No pharmacologic dilation · 45-degree field of view · acquired with a NIDEK AFC-230 · image size 848x848 · posterior pole color fundus photograph.
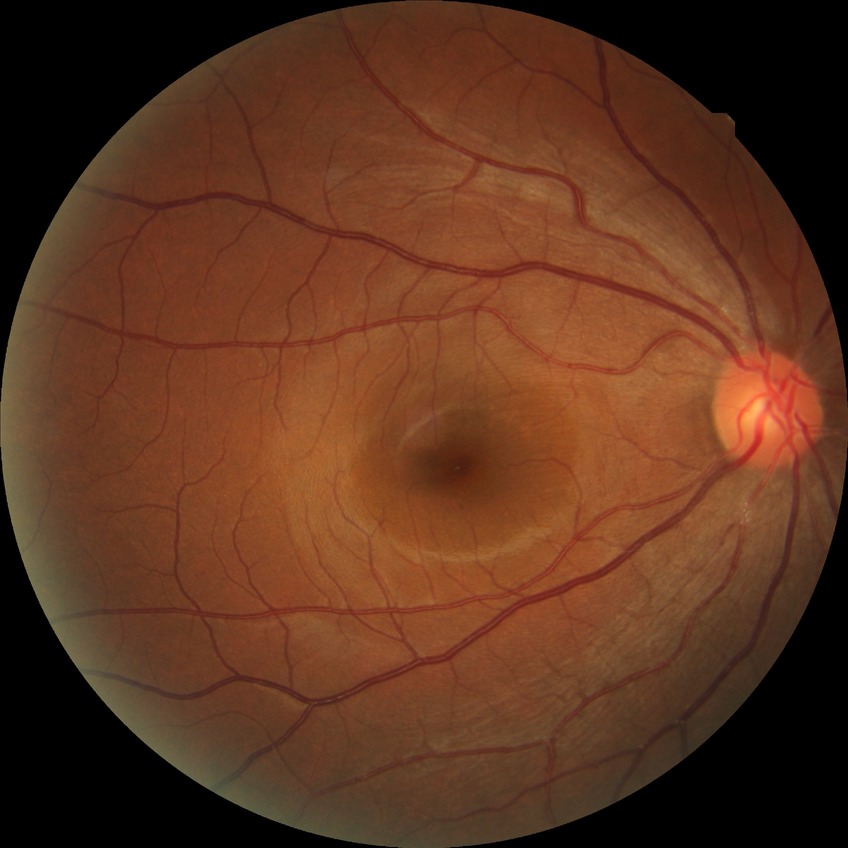 davis_grade: no diabetic retinopathy (NDR)